2212 x 1659 pixels, FOV: 60 degrees, color fundus photograph from a handheld portable camera
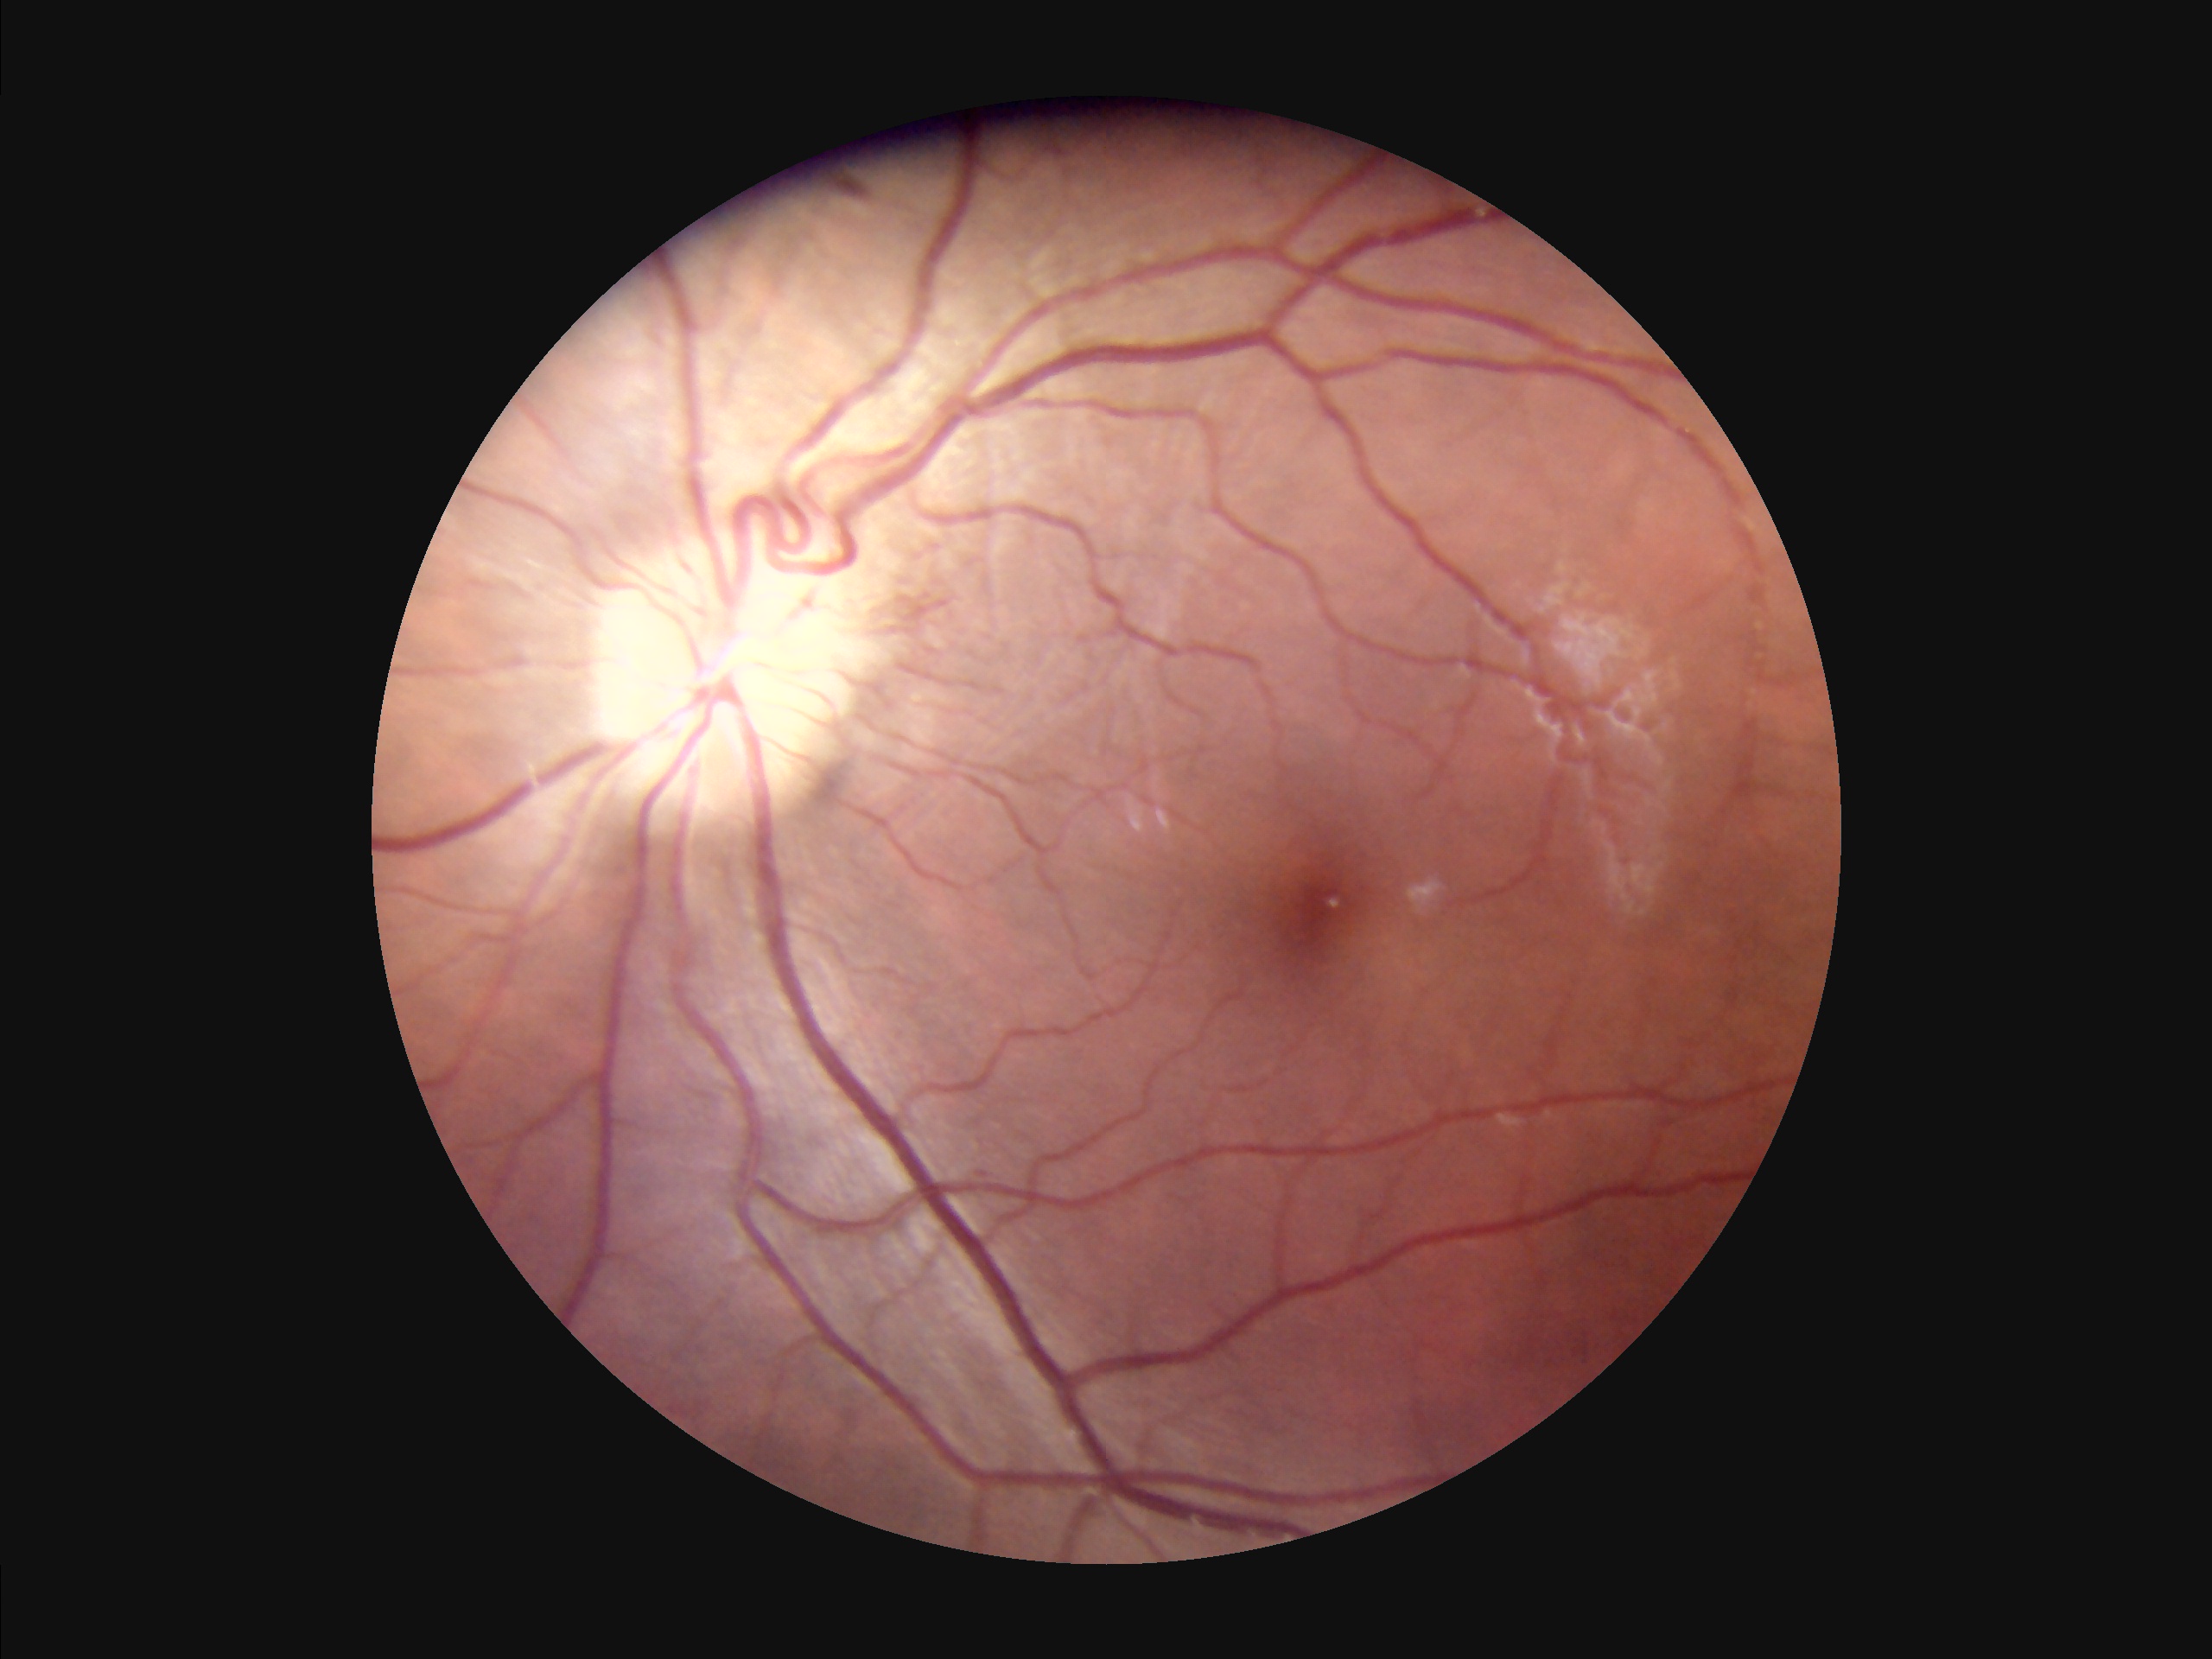
{"contrast": "good", "overall_quality": "good", "clarity": "clear", "illumination": "even"}